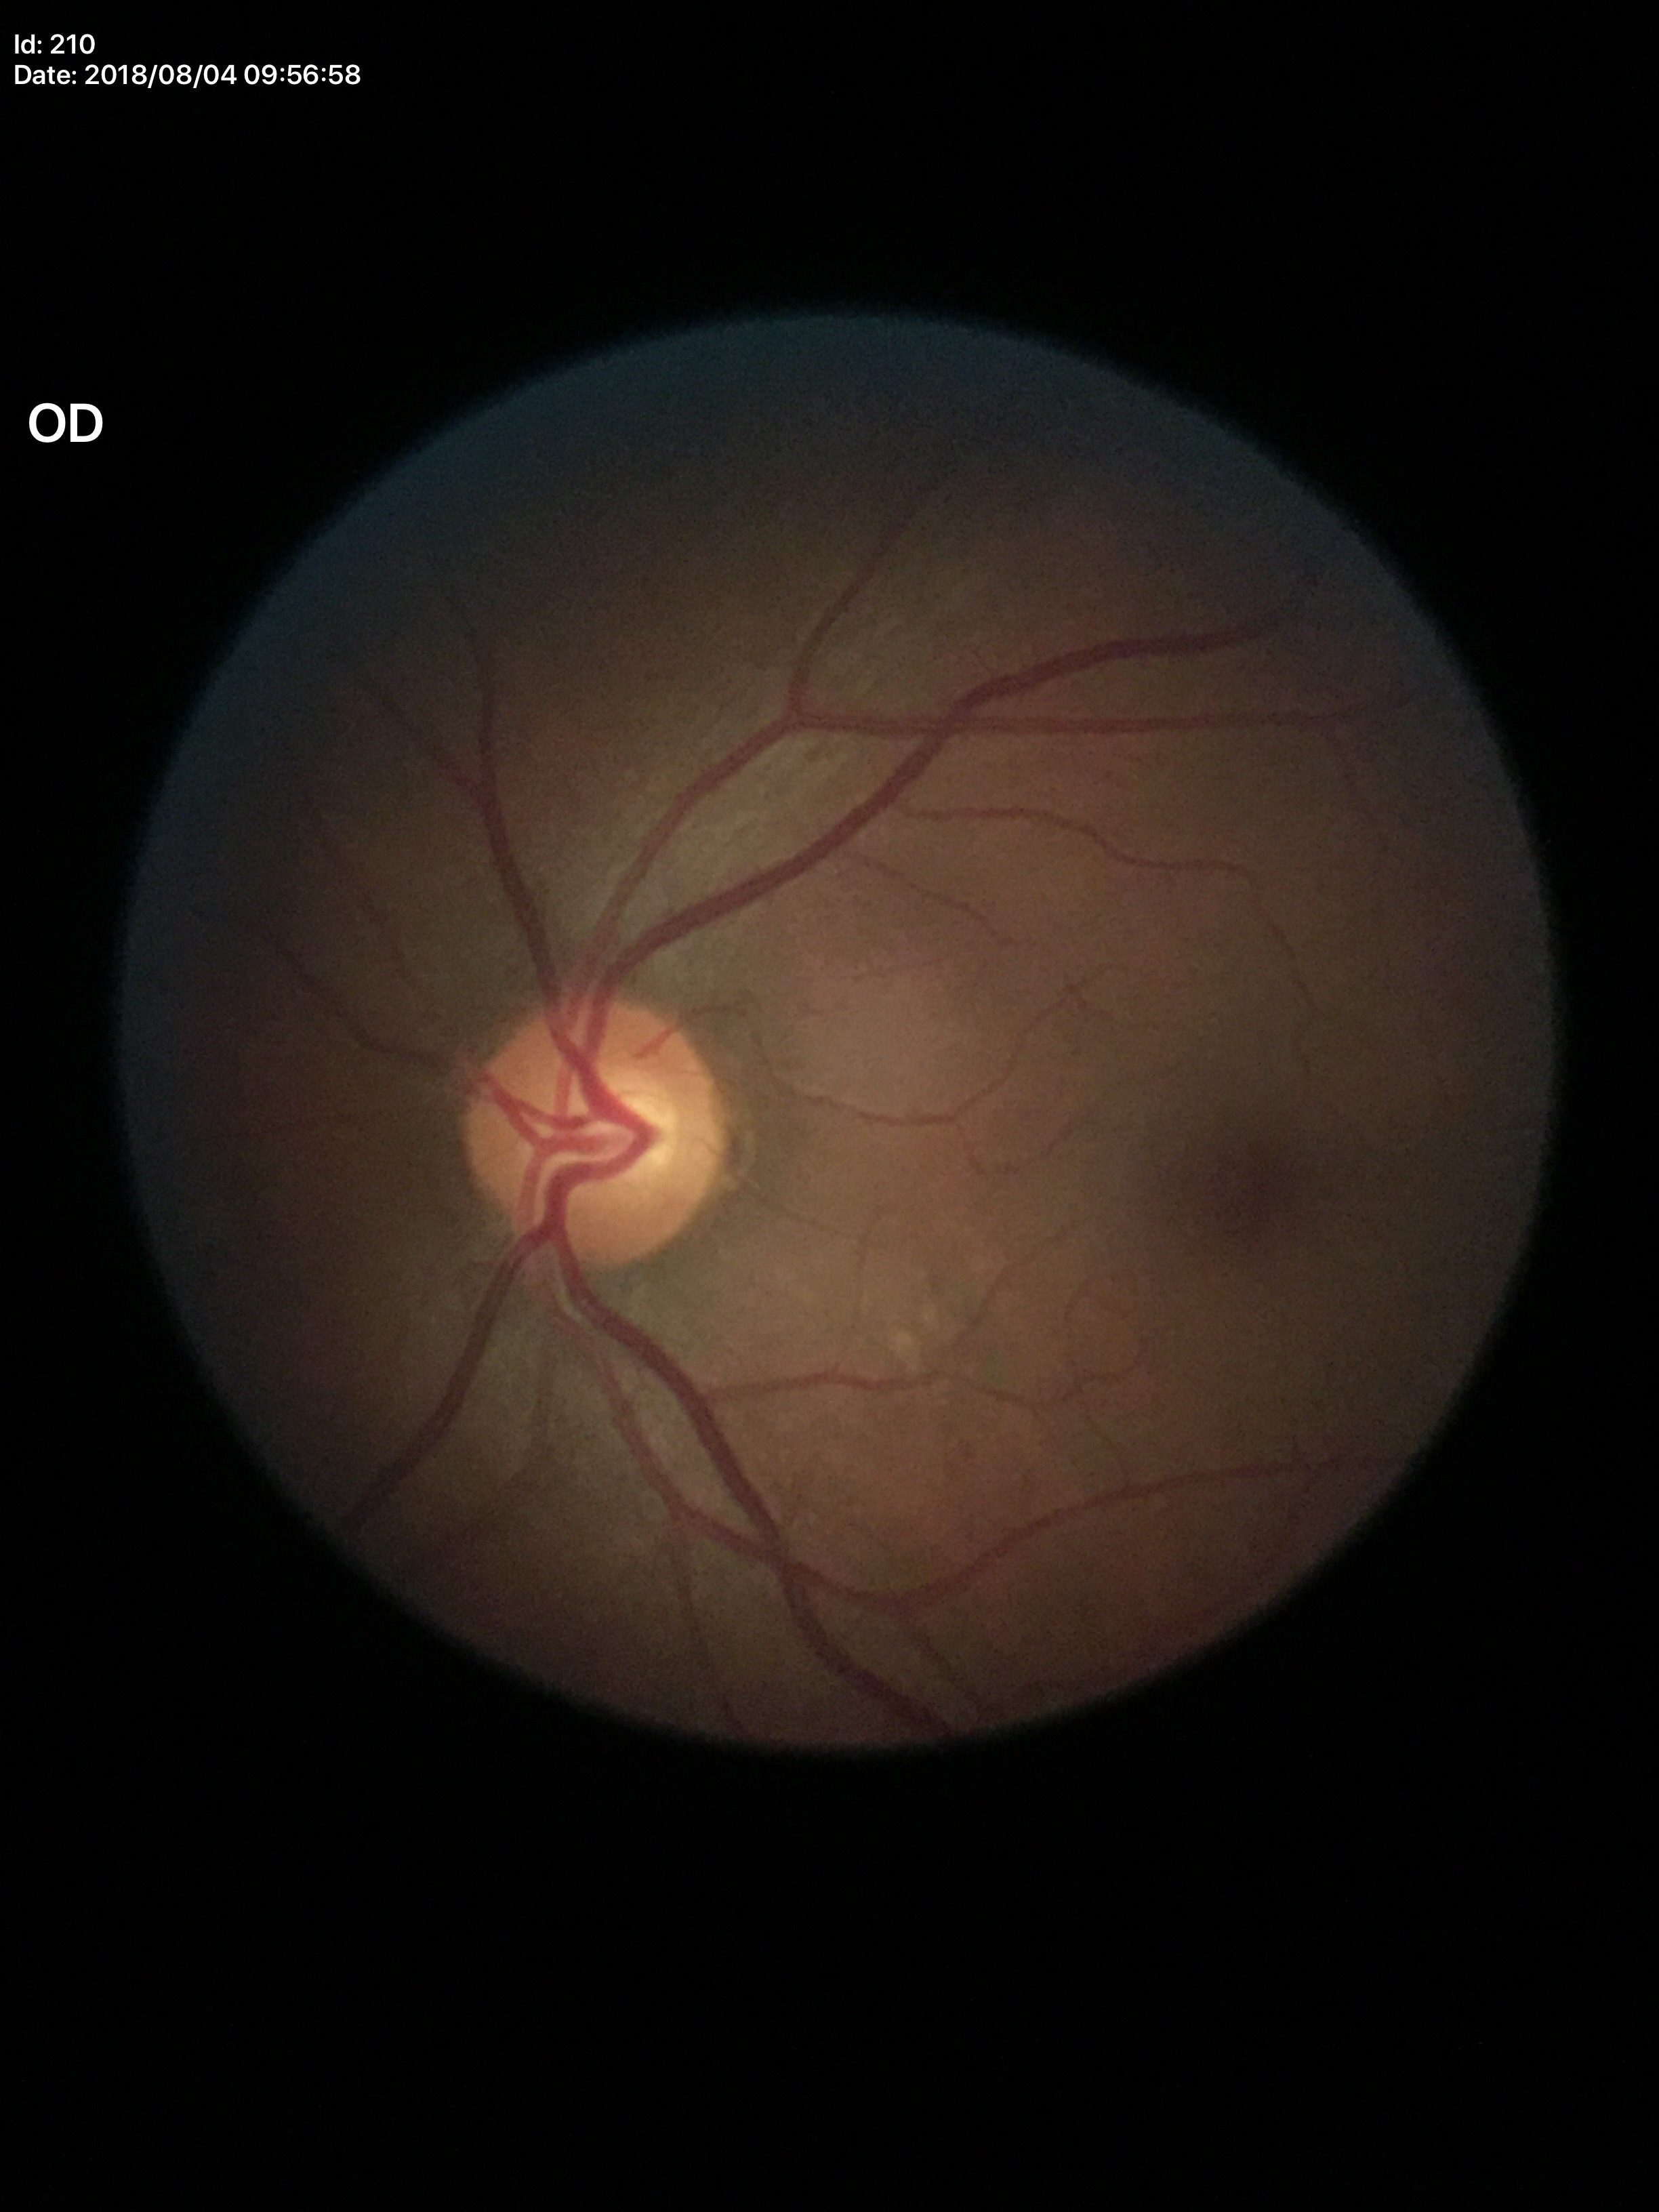
Q: What is the horizontal cup-to-disc ratio?
A: 0.61
Q: Glaucoma screening result?
A: not suspect
Q: What is the vertical cup-to-disc ratio?
A: 0.54